Image size 2352x1568, 45° FOV.
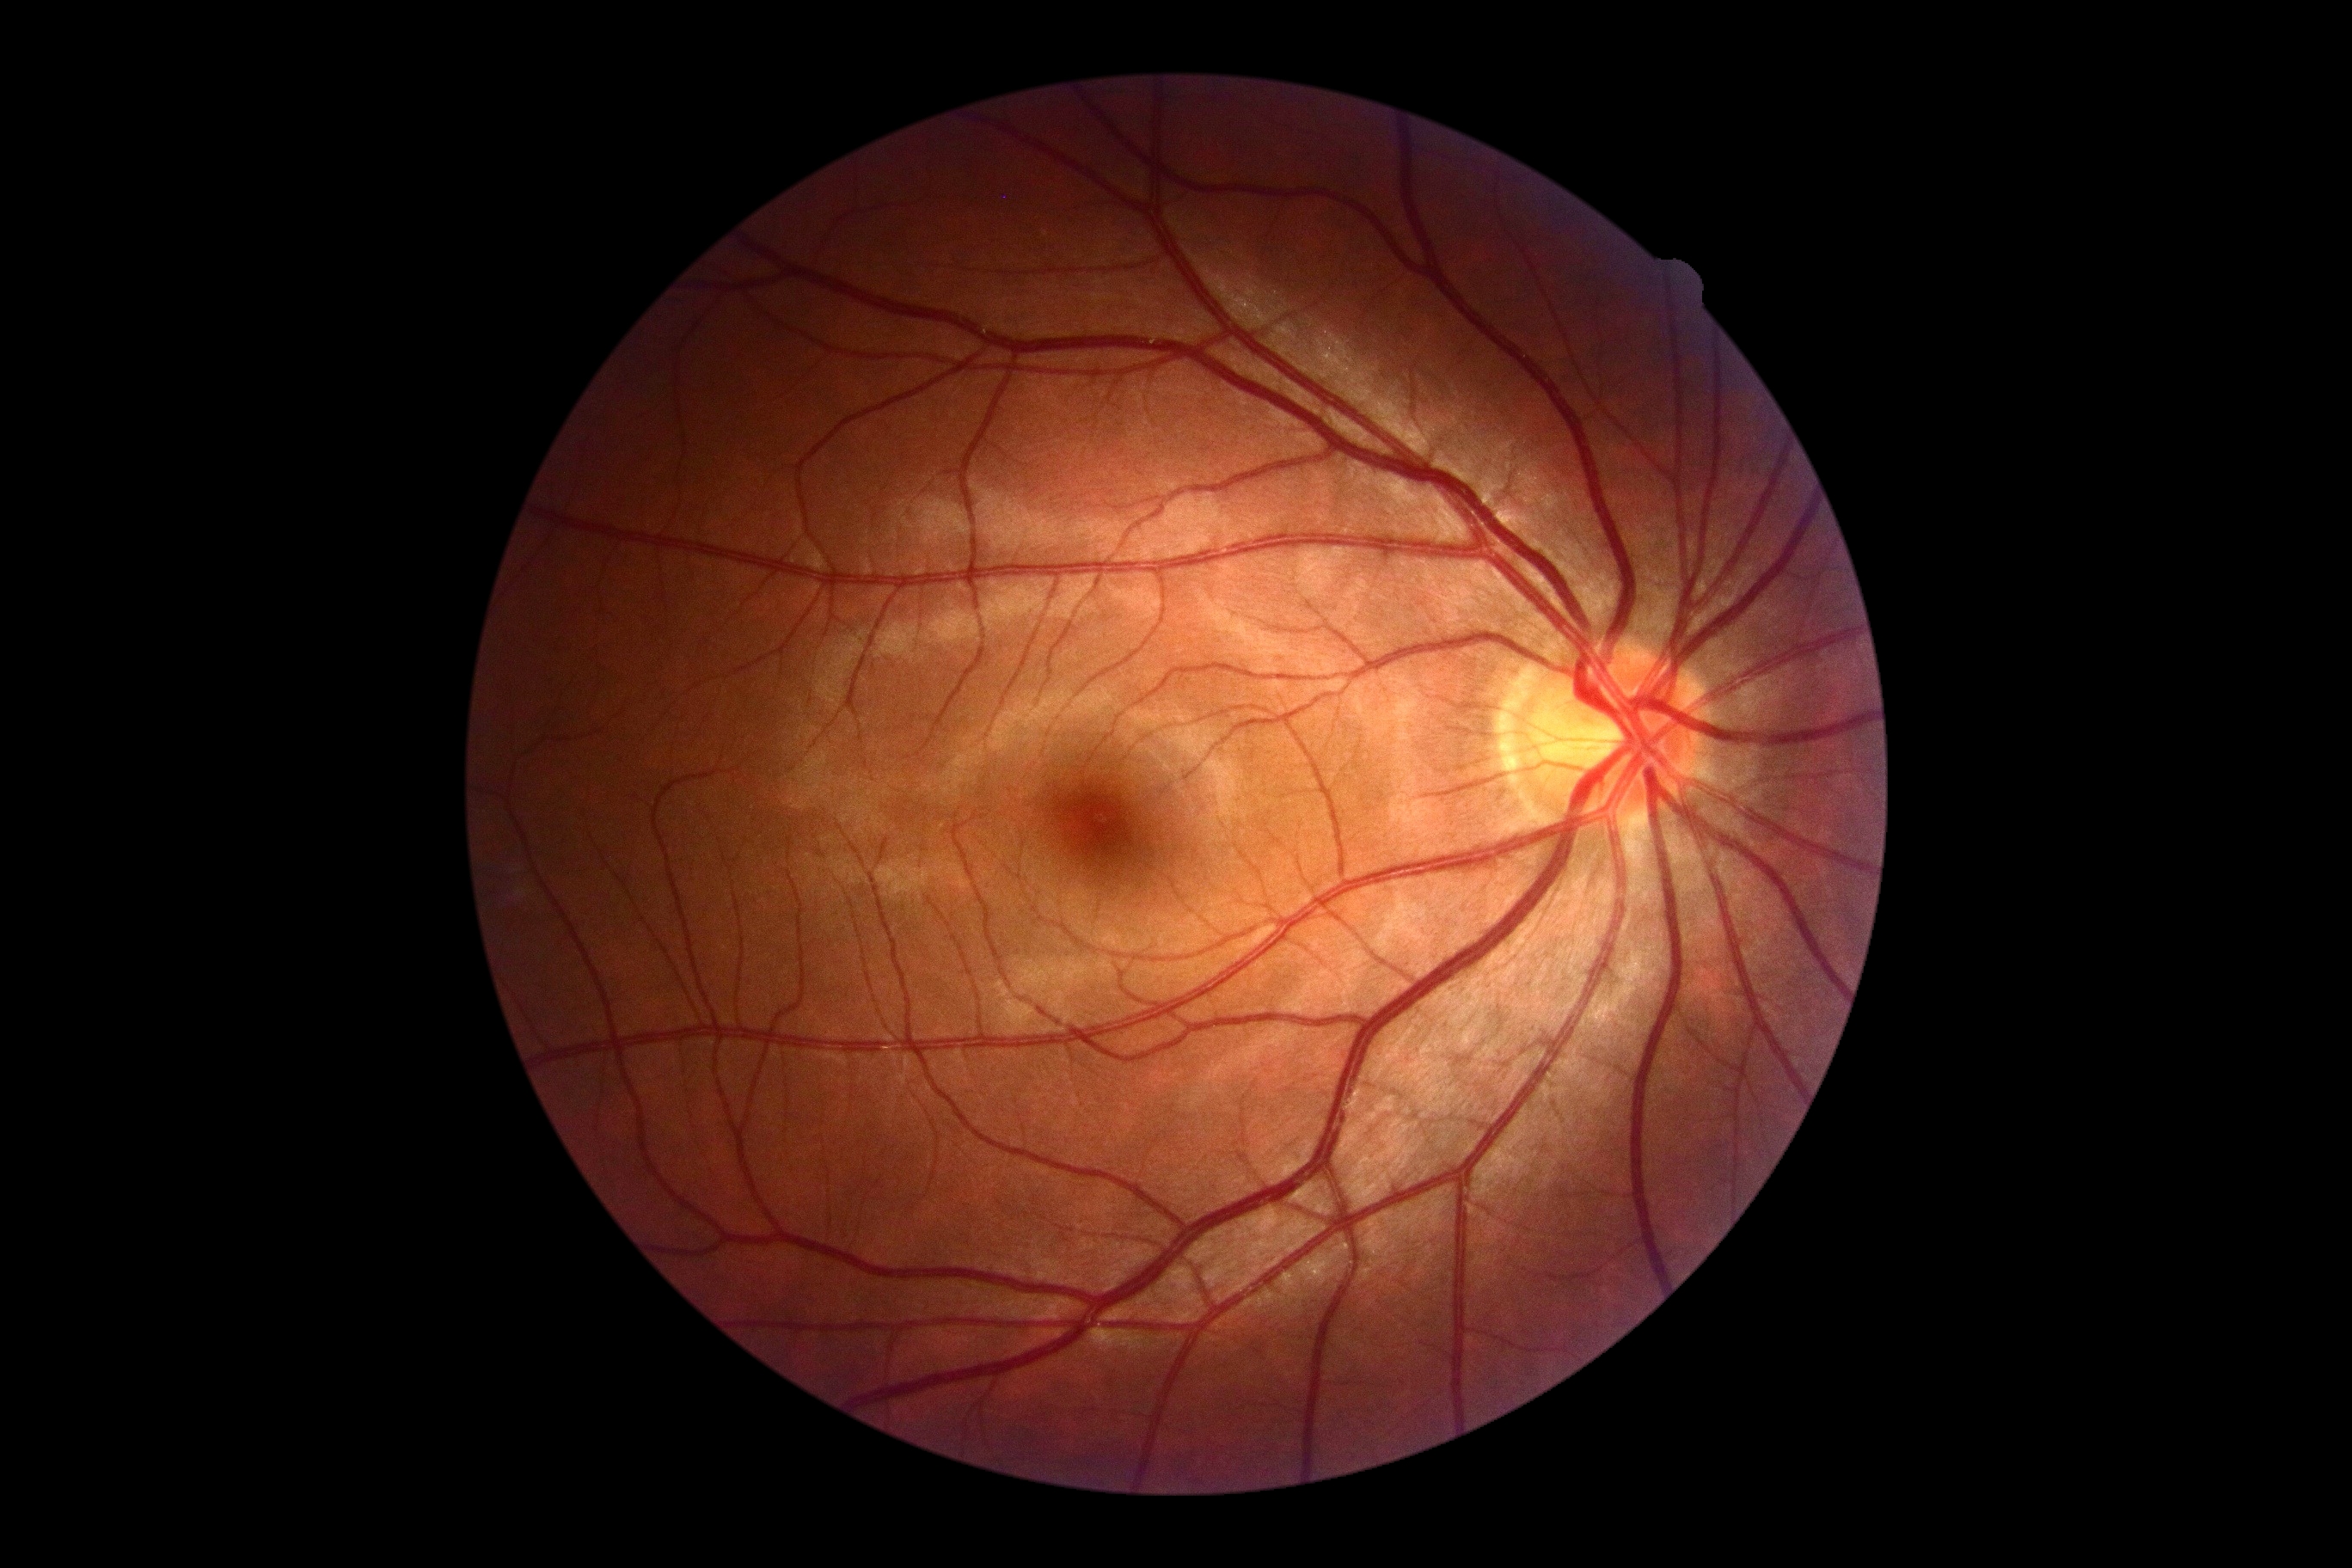

DR is grade 0 (no apparent retinopathy).